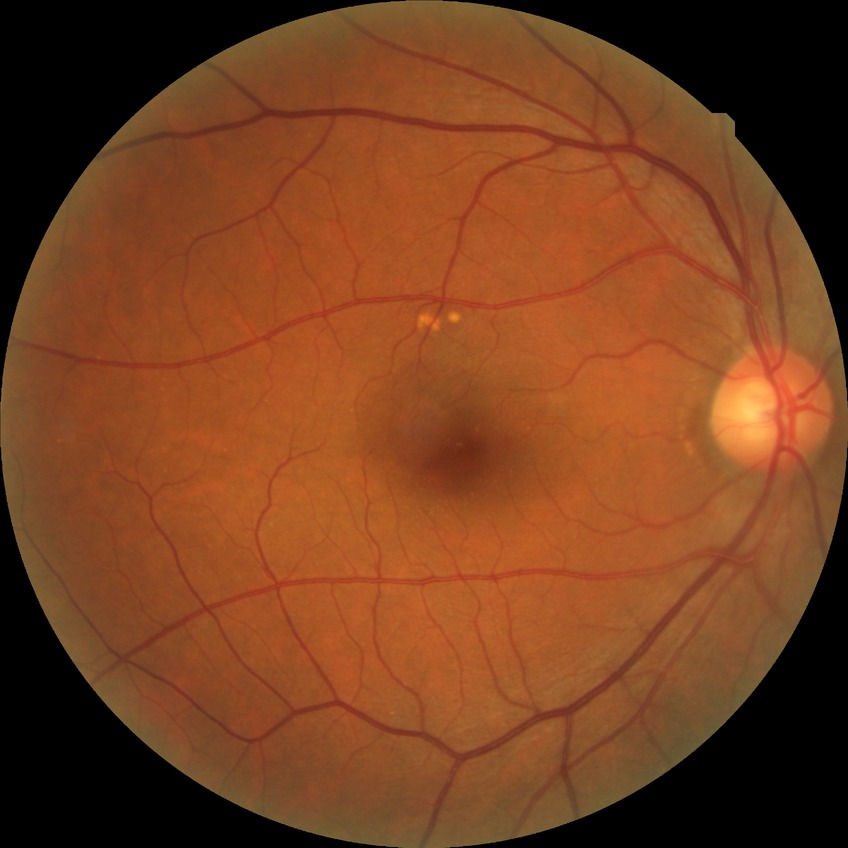

Diabetic retinopathy (DR) is no diabetic retinopathy (NDR).